FOV: 50 degrees; 2228x1652px; posterior pole field covering the optic disc and macula; CFP: 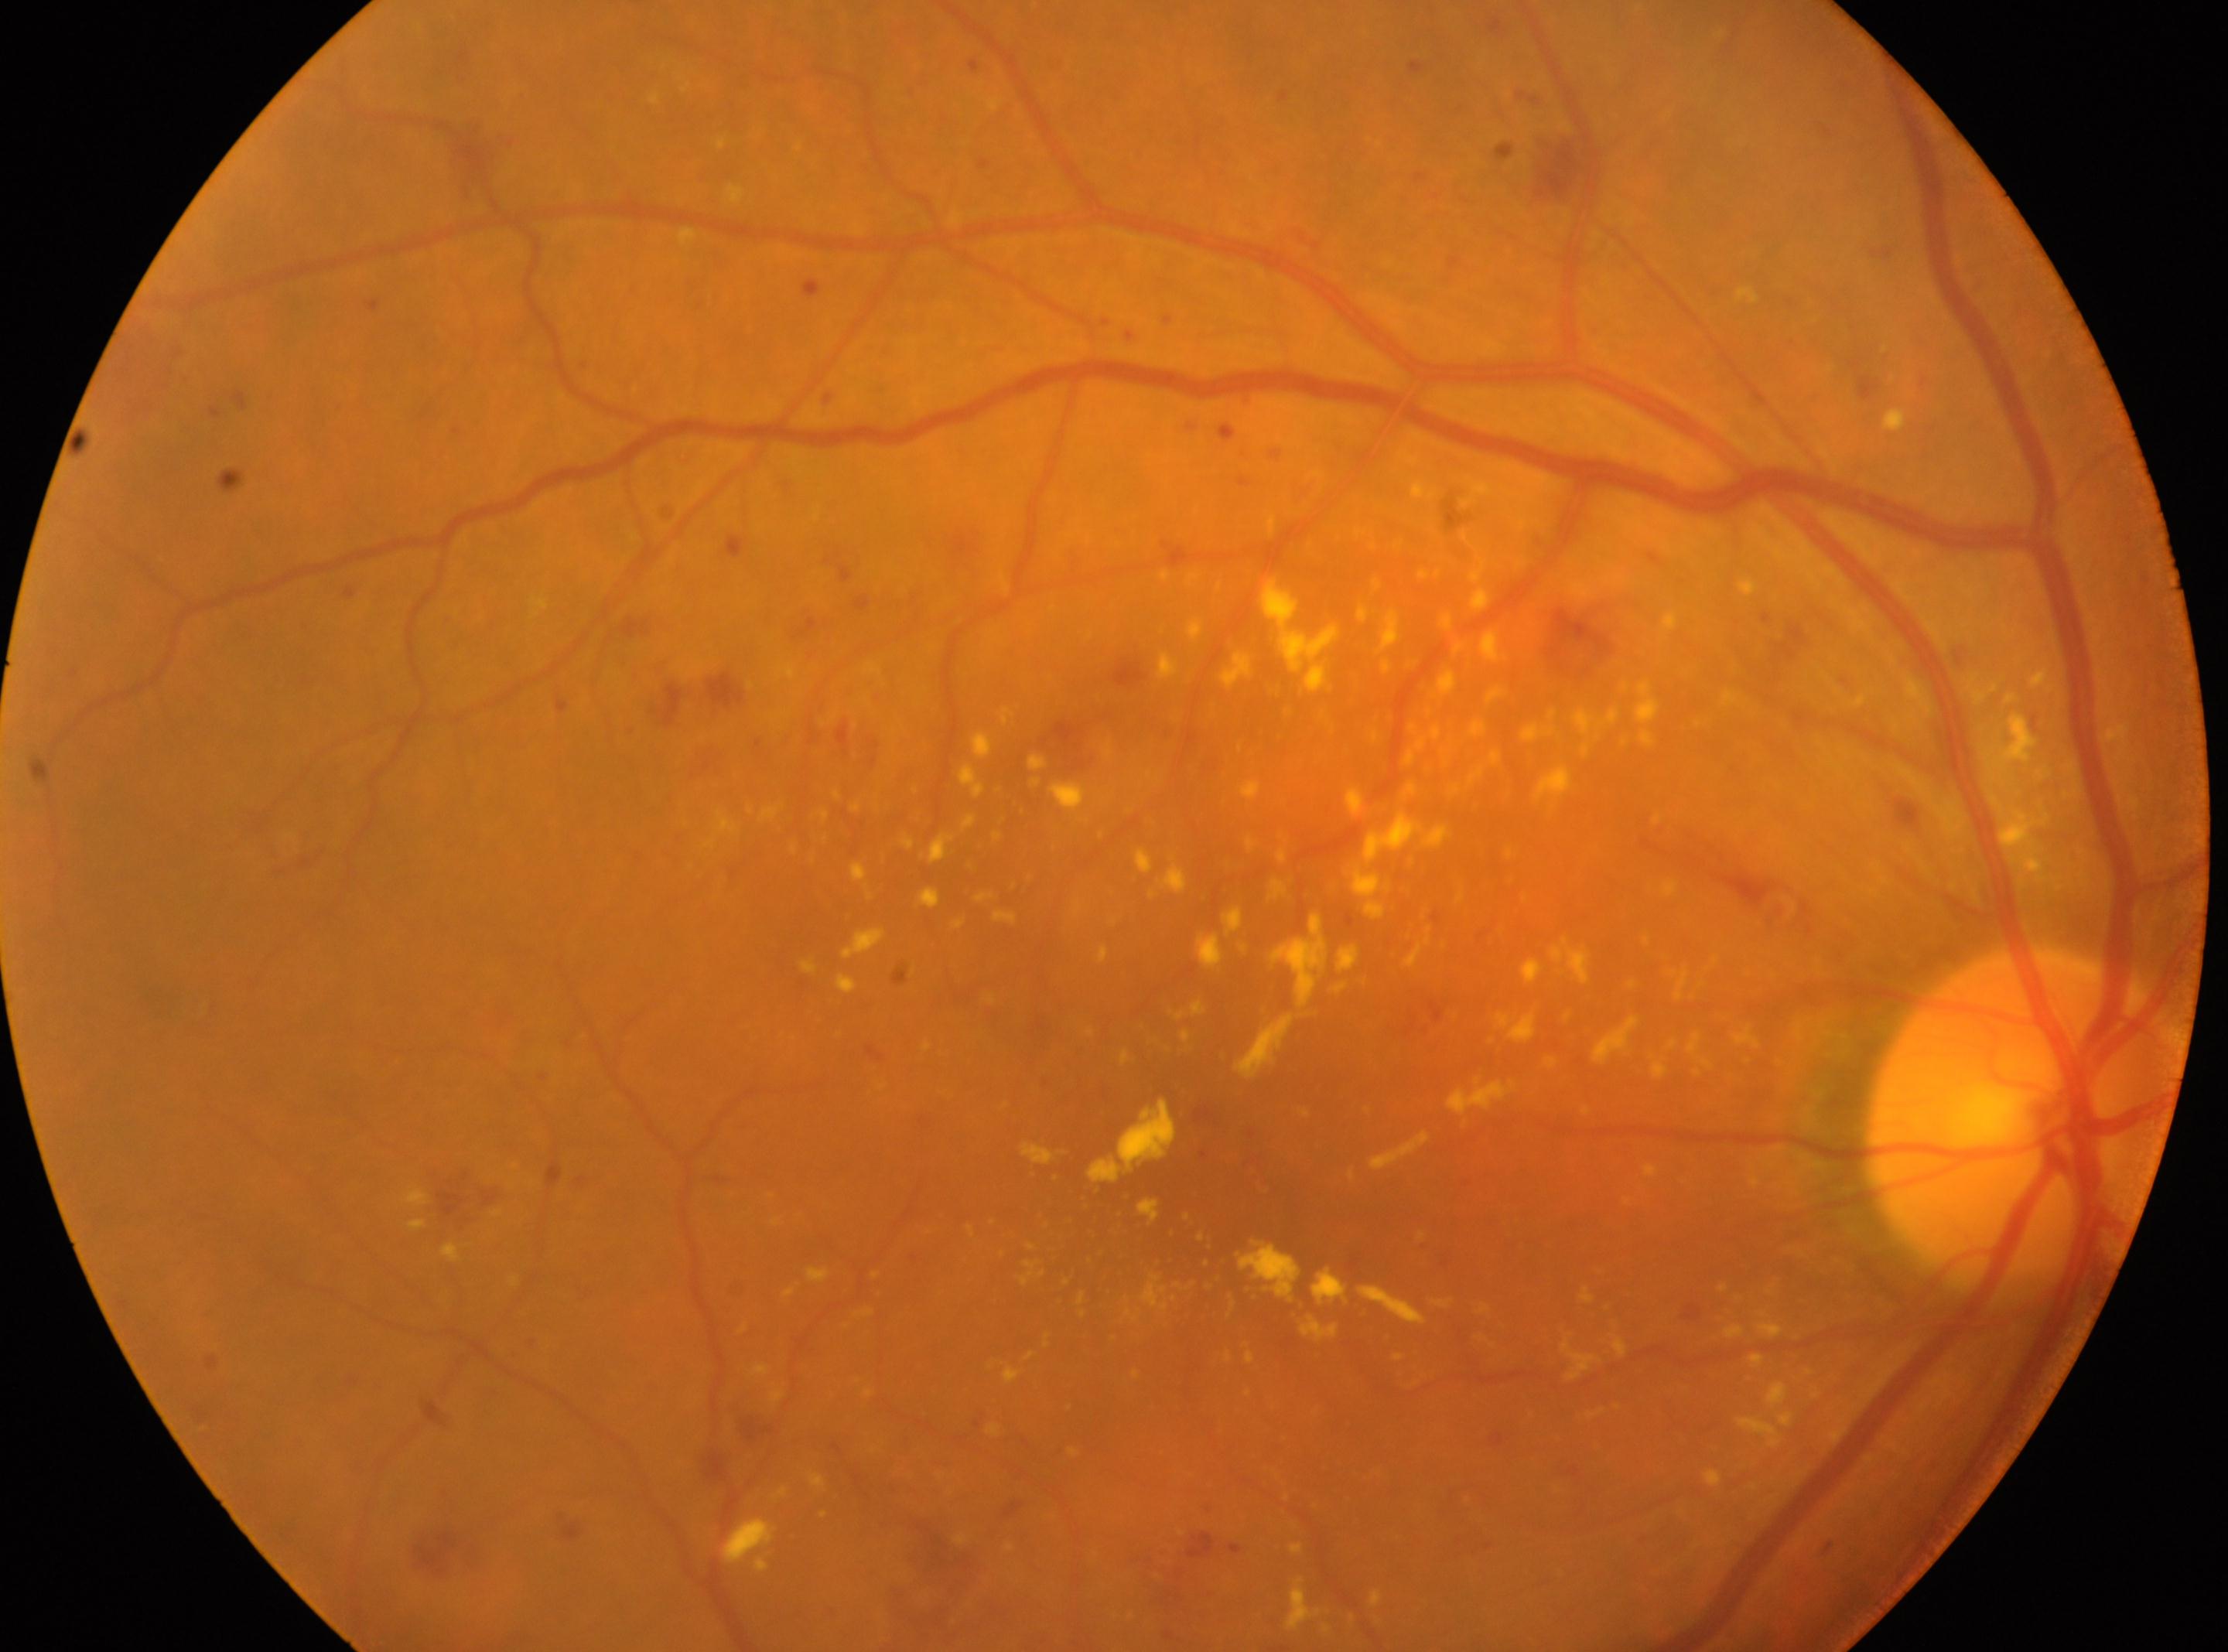 DR grade = 3/4 — more than 20 intraretinal hemorrhages in each of 4 quadrants, definite venous beading in 2 or more quadrants, or prominent intraretinal microvascular abnormalities in 1 or more quadrants, with no signs of proliferative retinopathy; DR class = non-proliferative diabetic retinopathy; optic disc = (x=2025, y=1115); laterality = oculus dexter; macula center = (x=1216, y=1171).